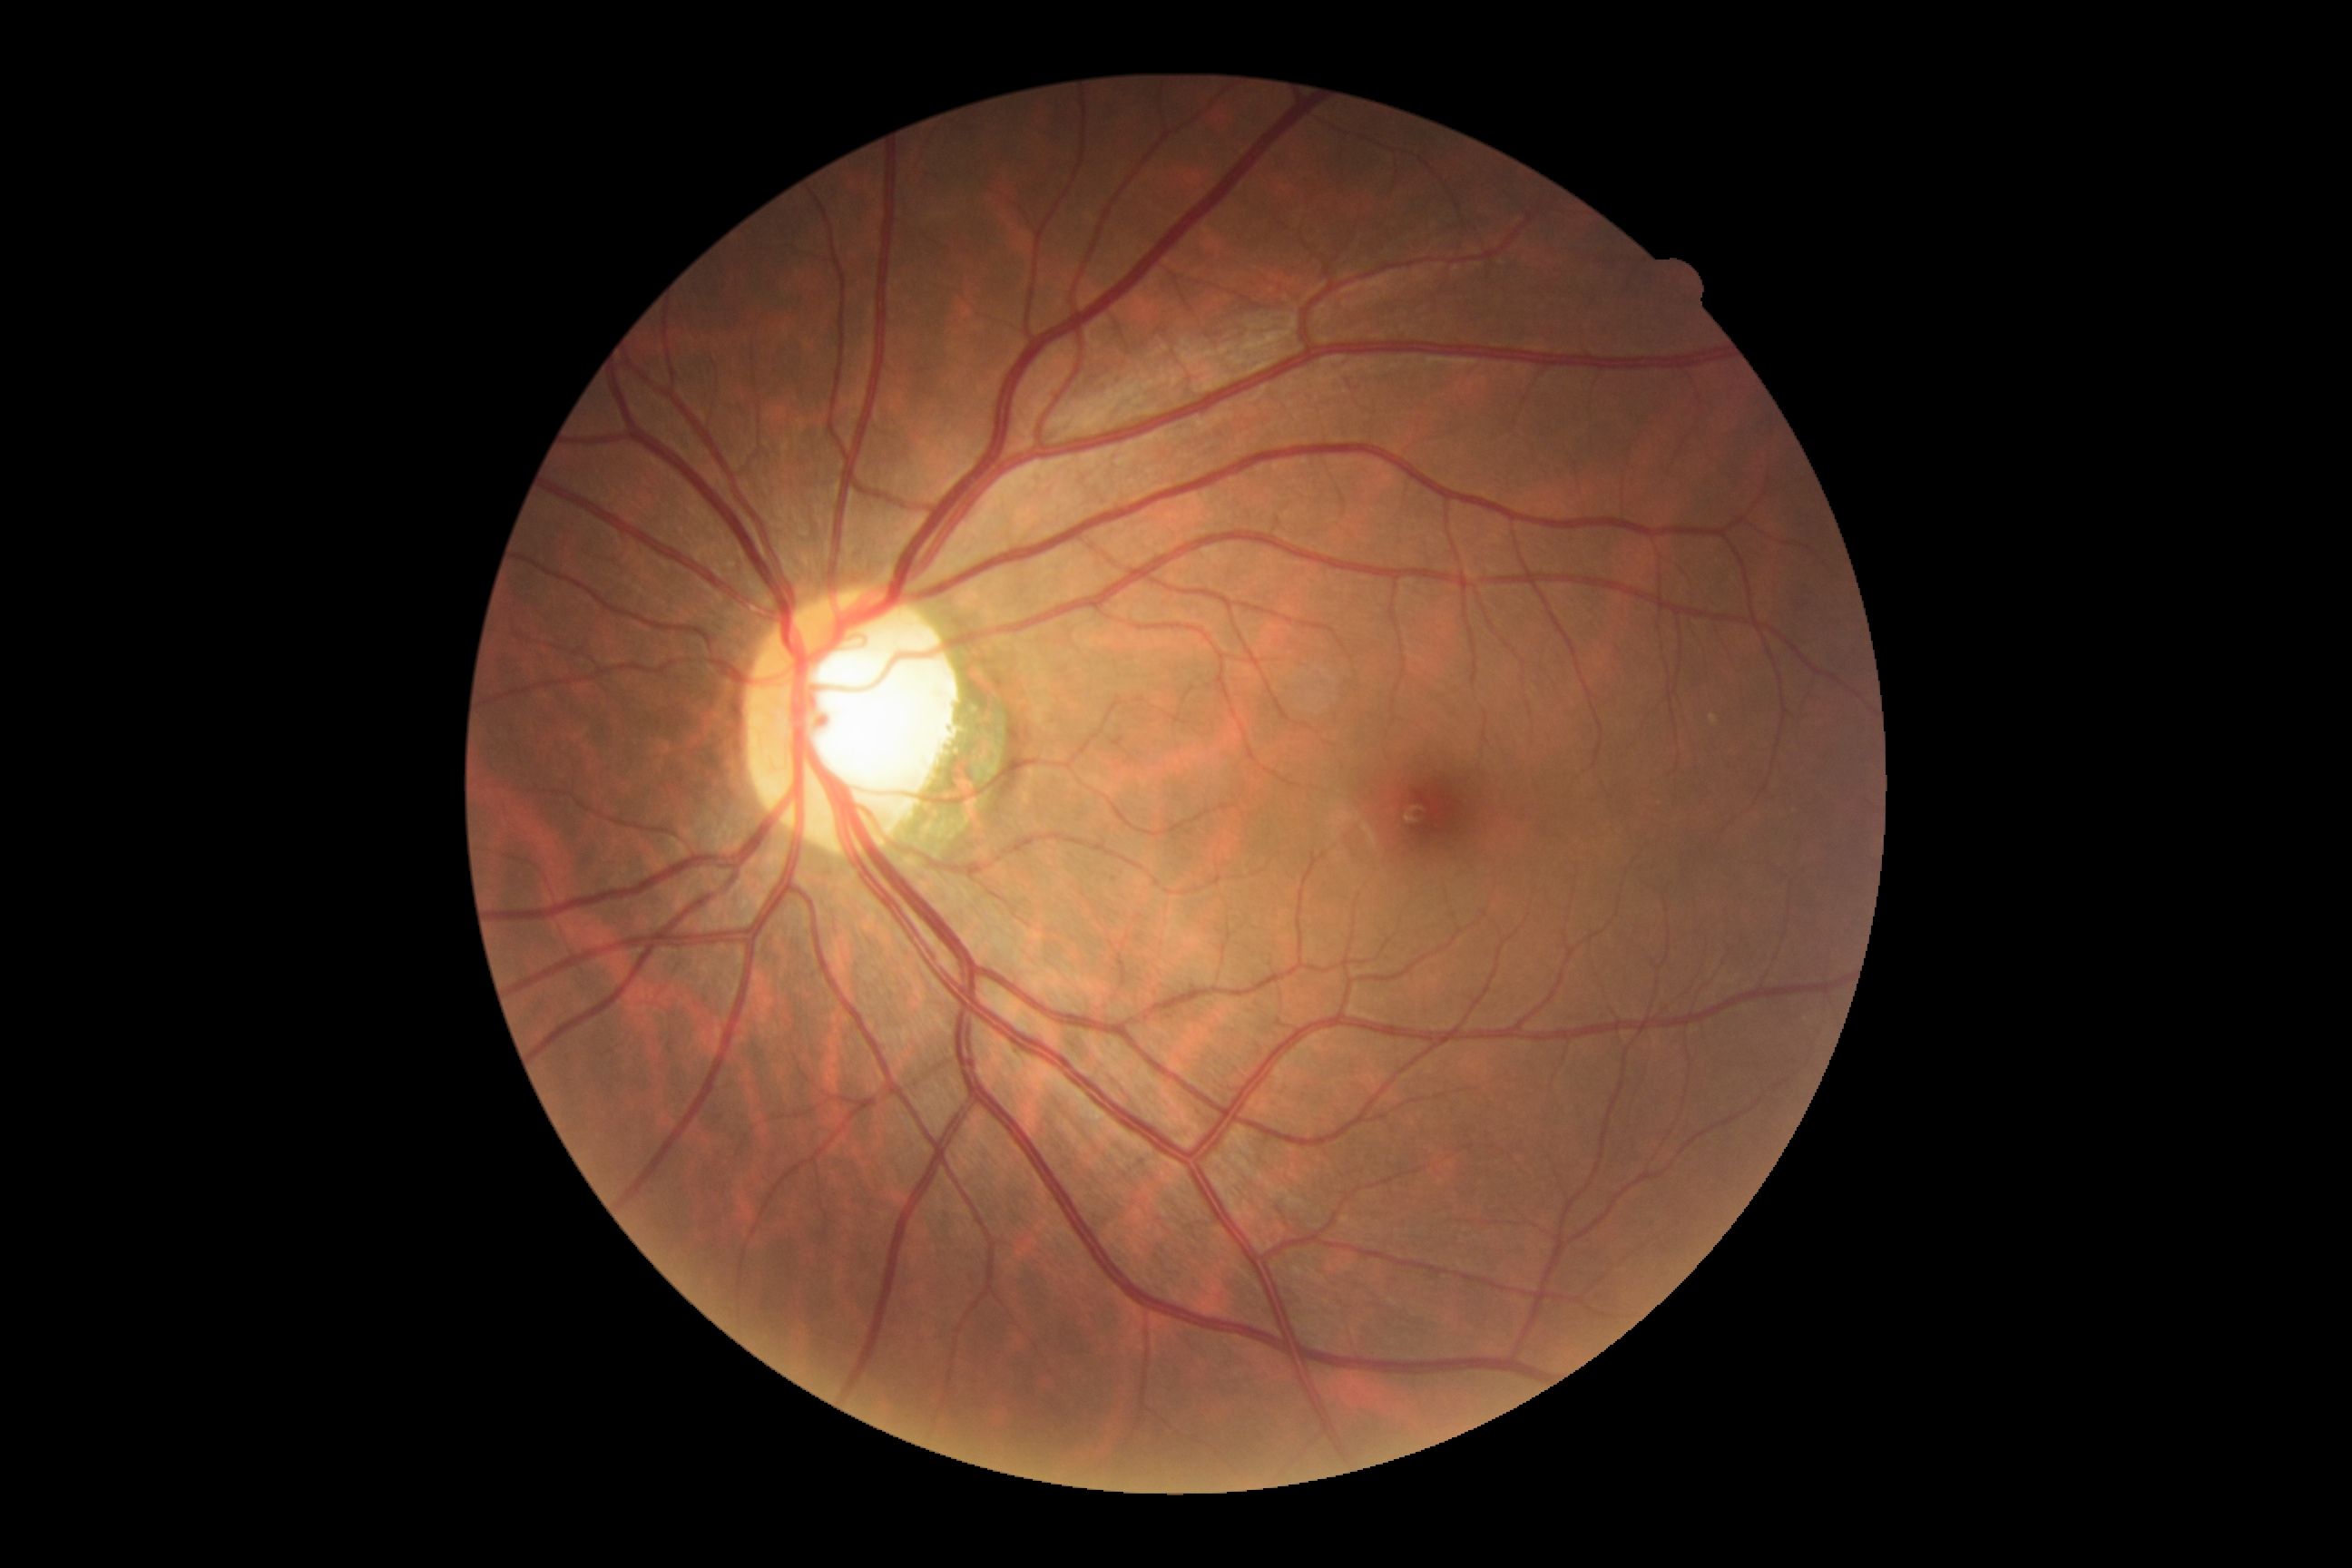

No apparent diabetic retinopathy. Diabetic retinopathy severity: grade 0 (no apparent retinopathy).